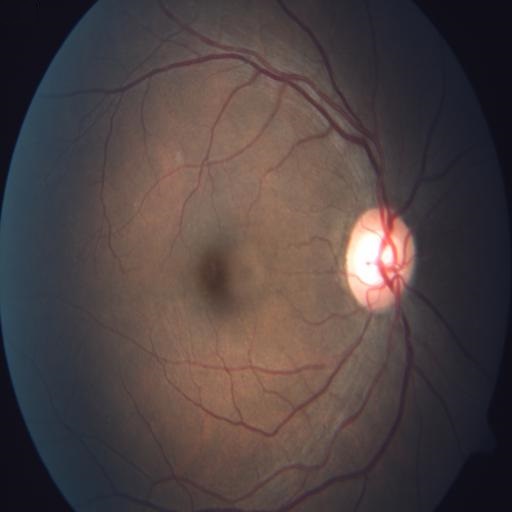 Demonstrates optic disc pallor.